Nonmydriatic. Posterior pole color fundus photograph — 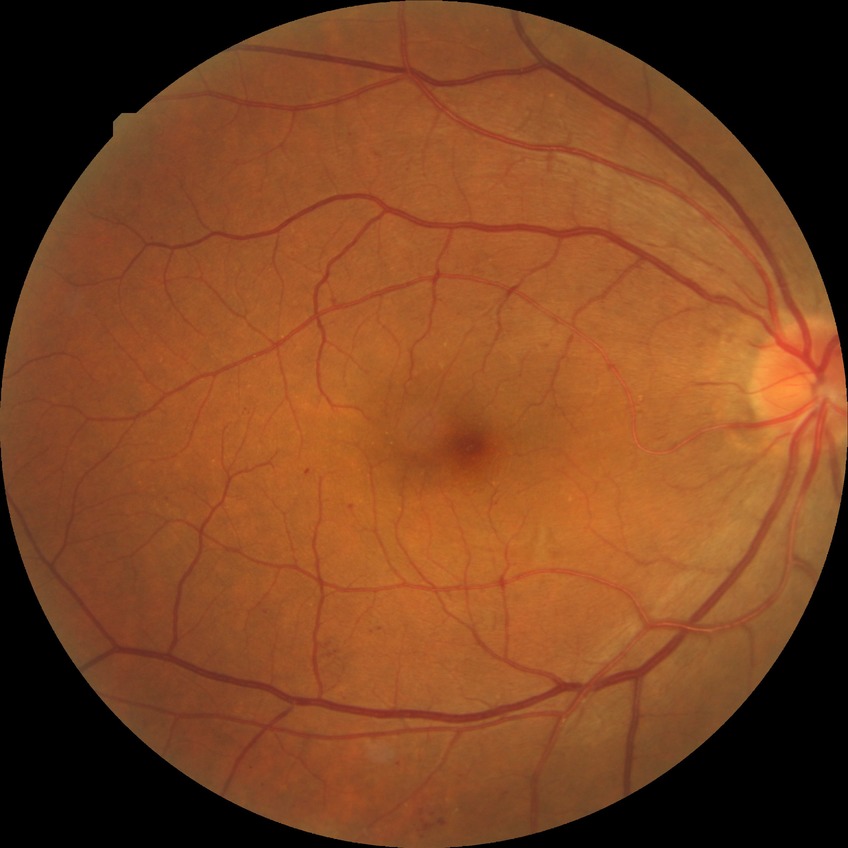
Diabetic retinopathy (DR): SDR (simple diabetic retinopathy).